Image size 2212x1659. Color fundus image: 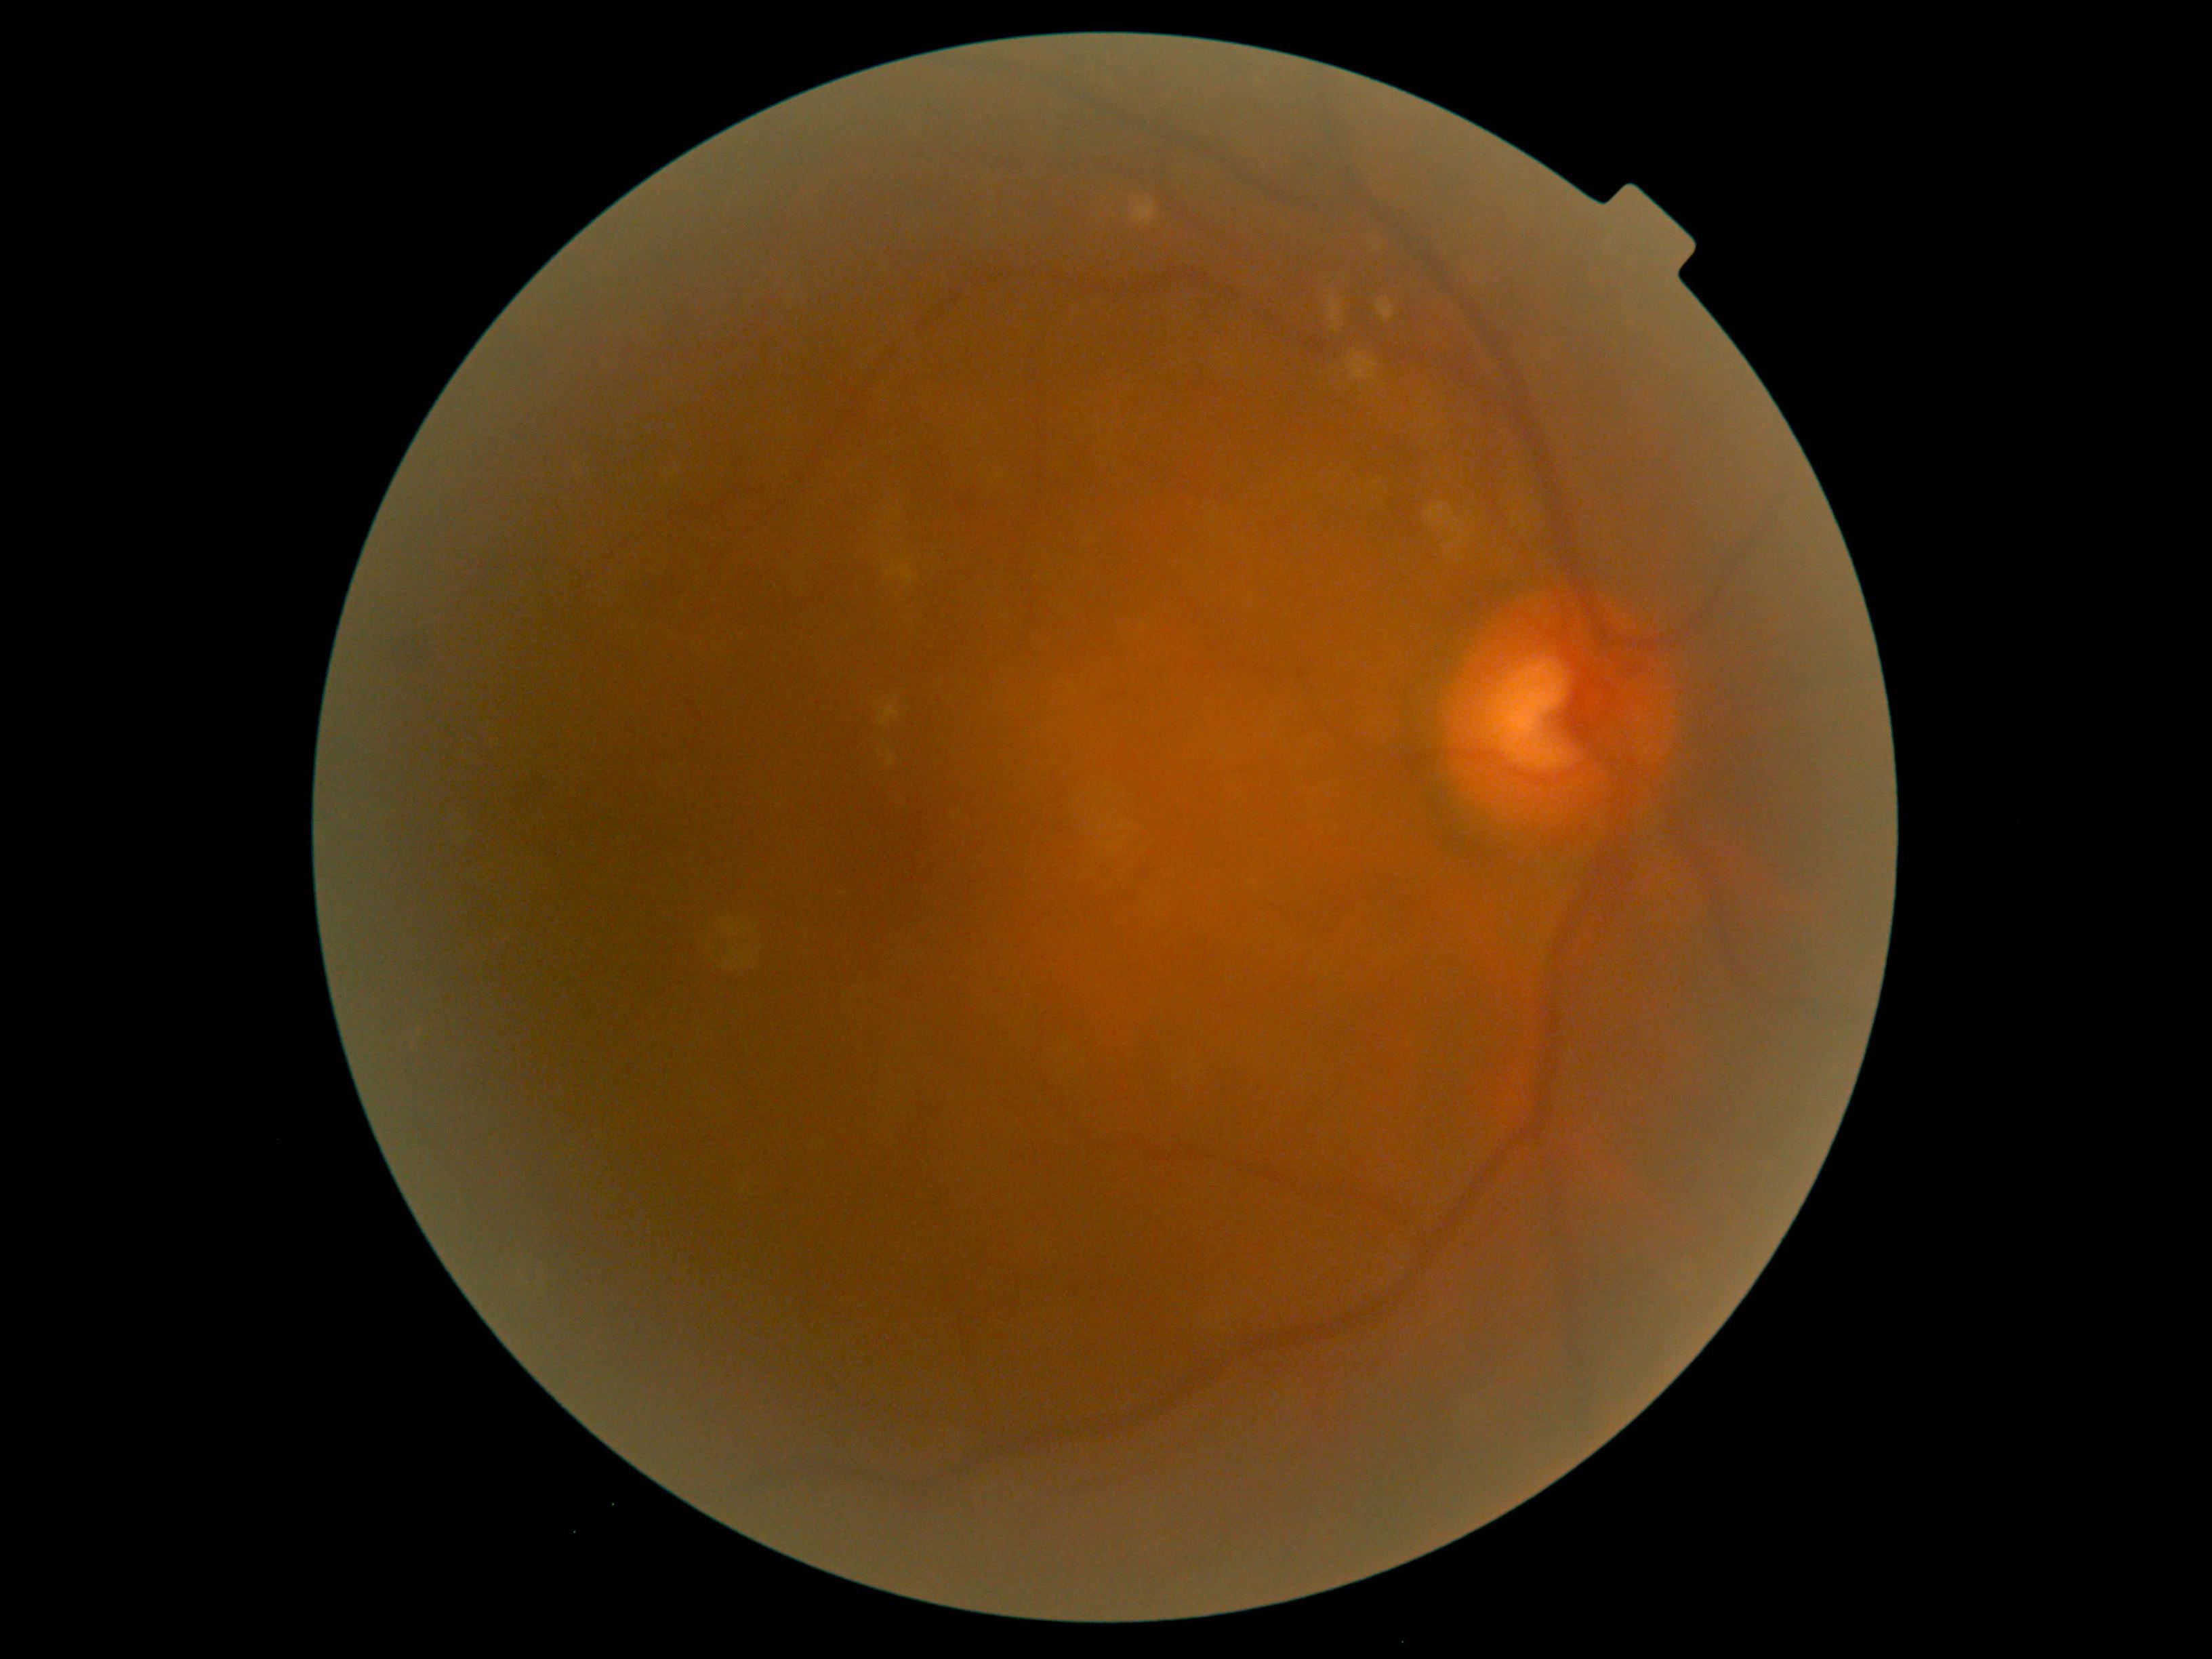
{"dr_category": "non-proliferative diabetic retinopathy", "dr_grade": "2 — more than just microaneurysms but less than severe NPDR"}